Nonmydriatic fundus photograph, modified Davis classification: 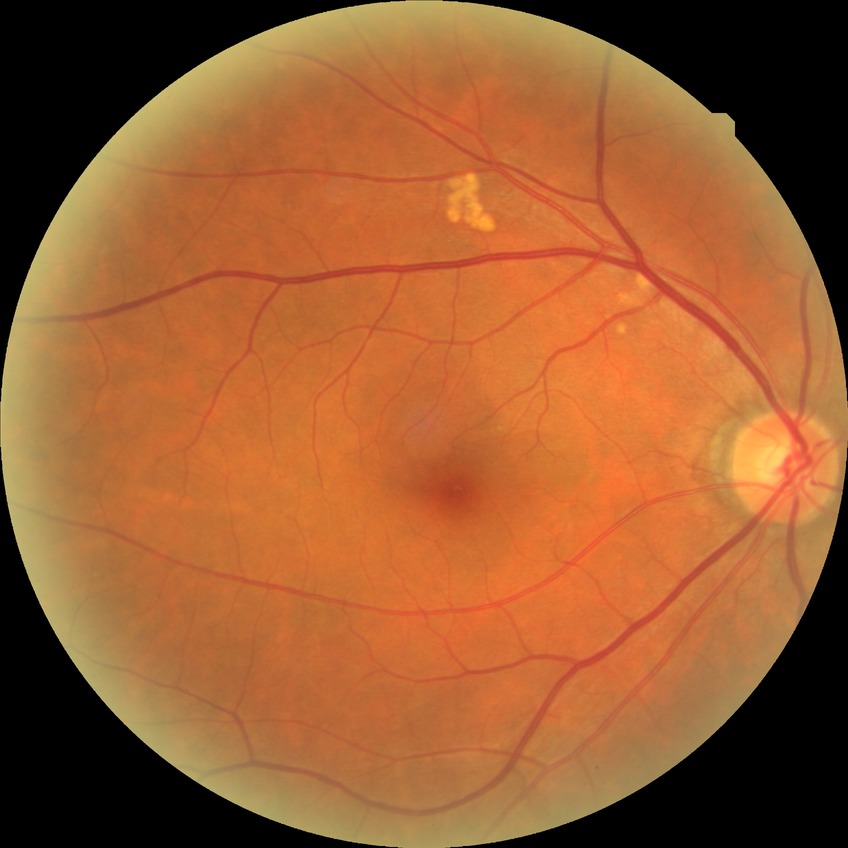
DR impression = no DR findings, Davis stage = NDR.